2048 x 1536 pixels.
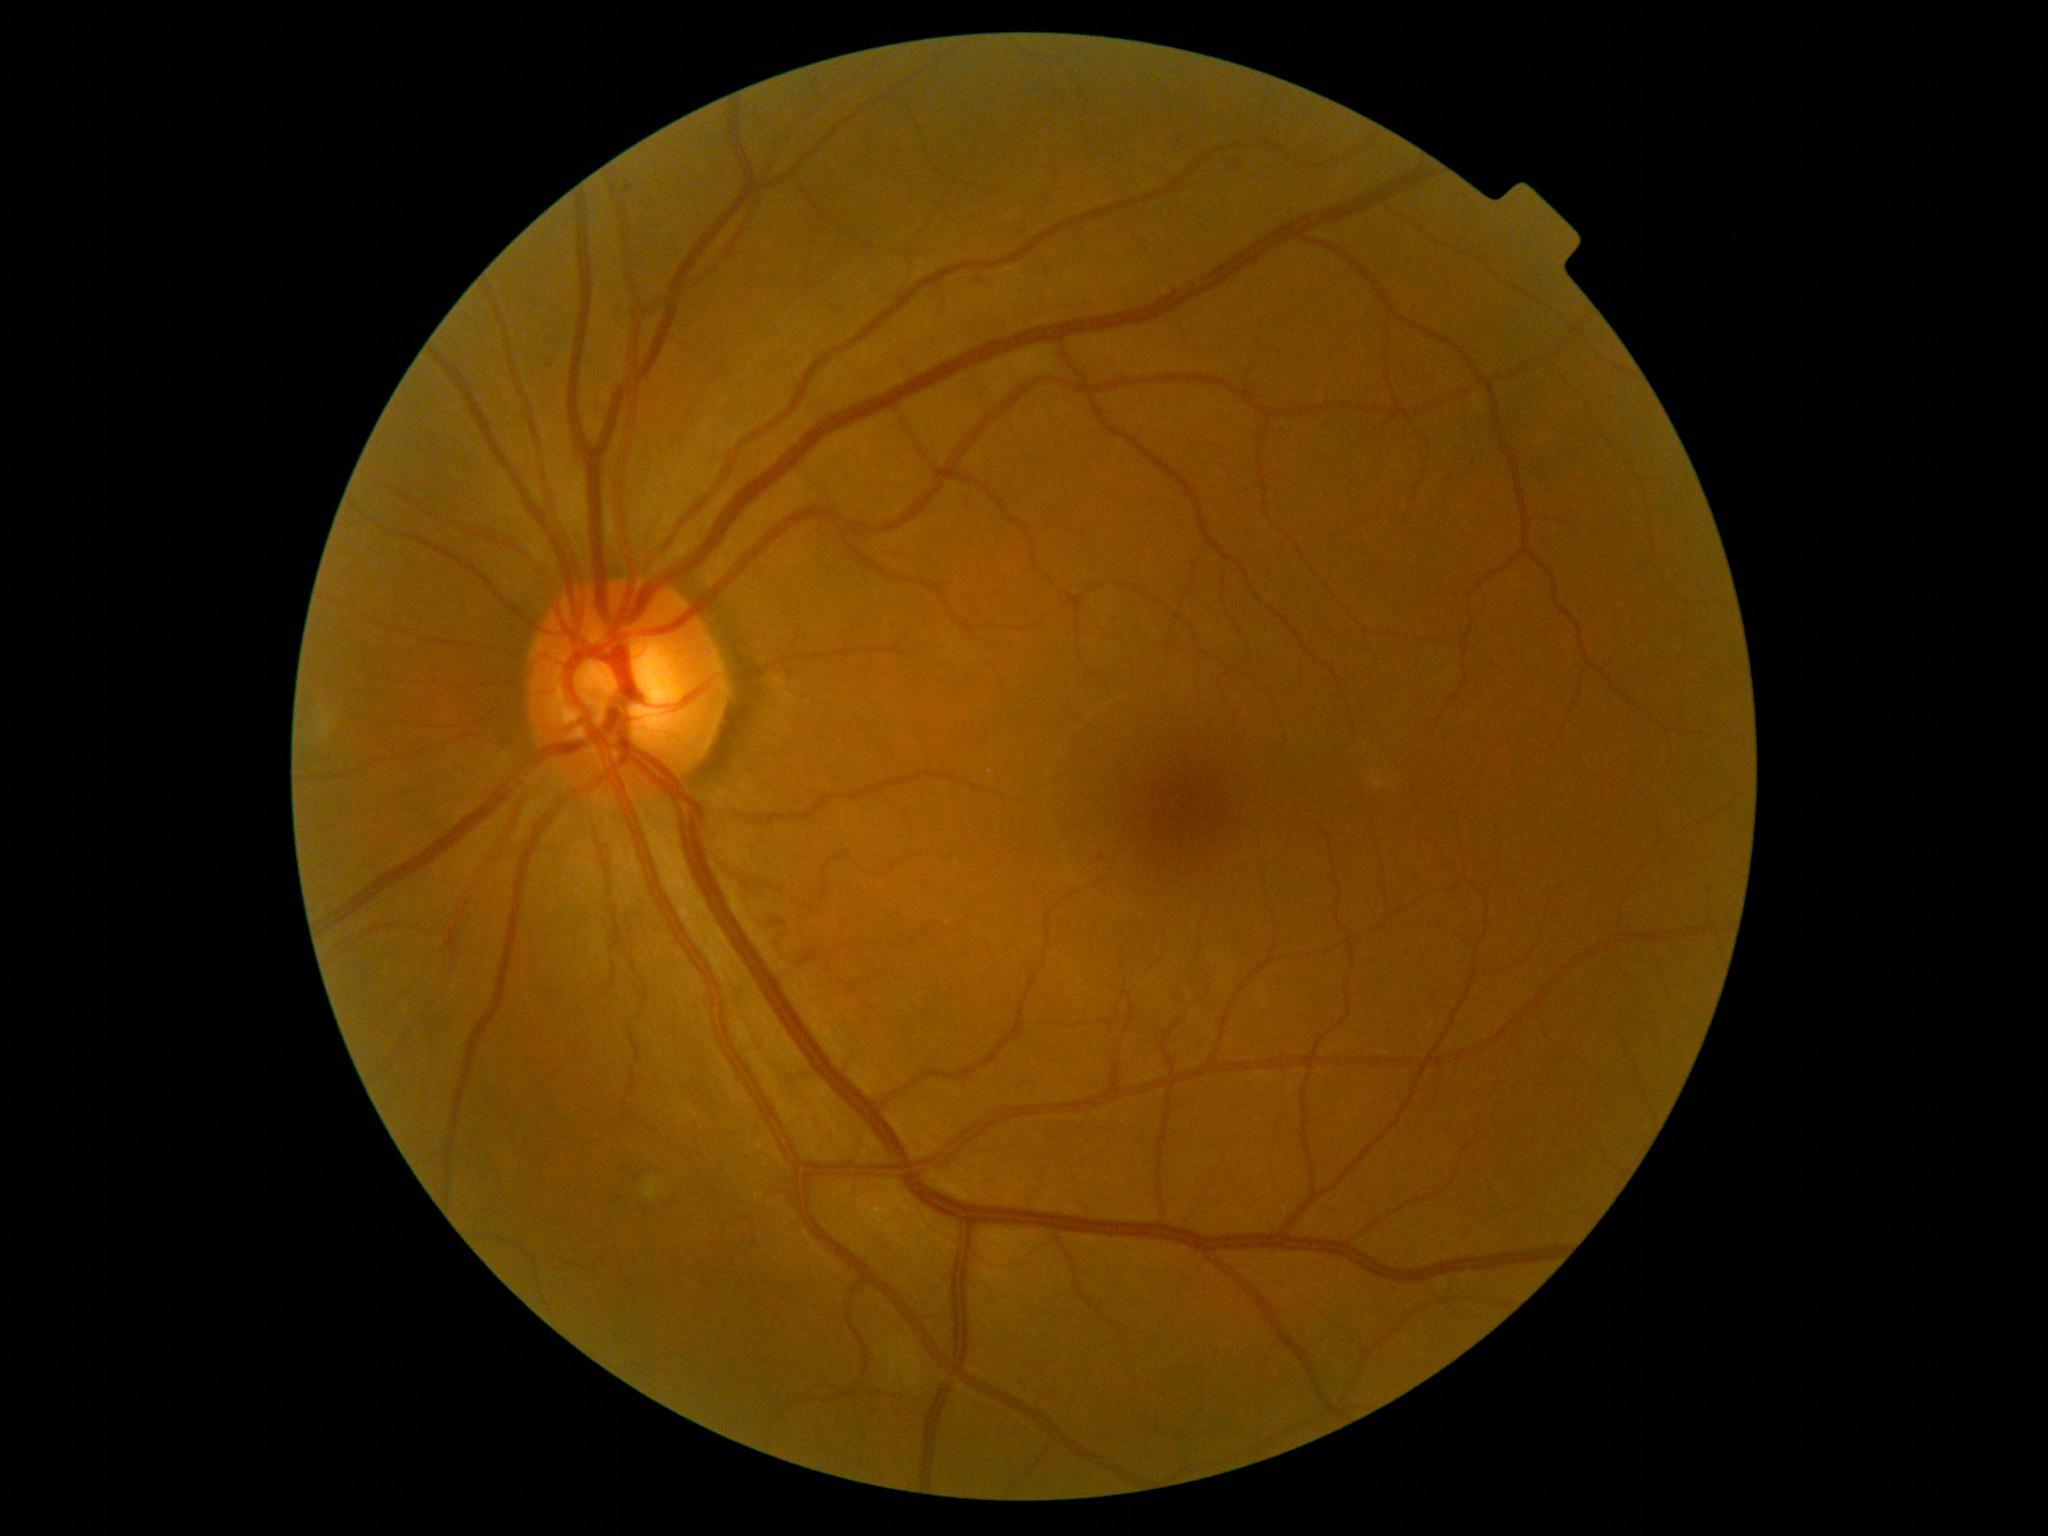
DR class@non-proliferative diabetic retinopathy; retinopathy grade@moderate NPDR (2) — more than just microaneurysms but less than severe NPDR.